Fundus photo · 50° FOV — 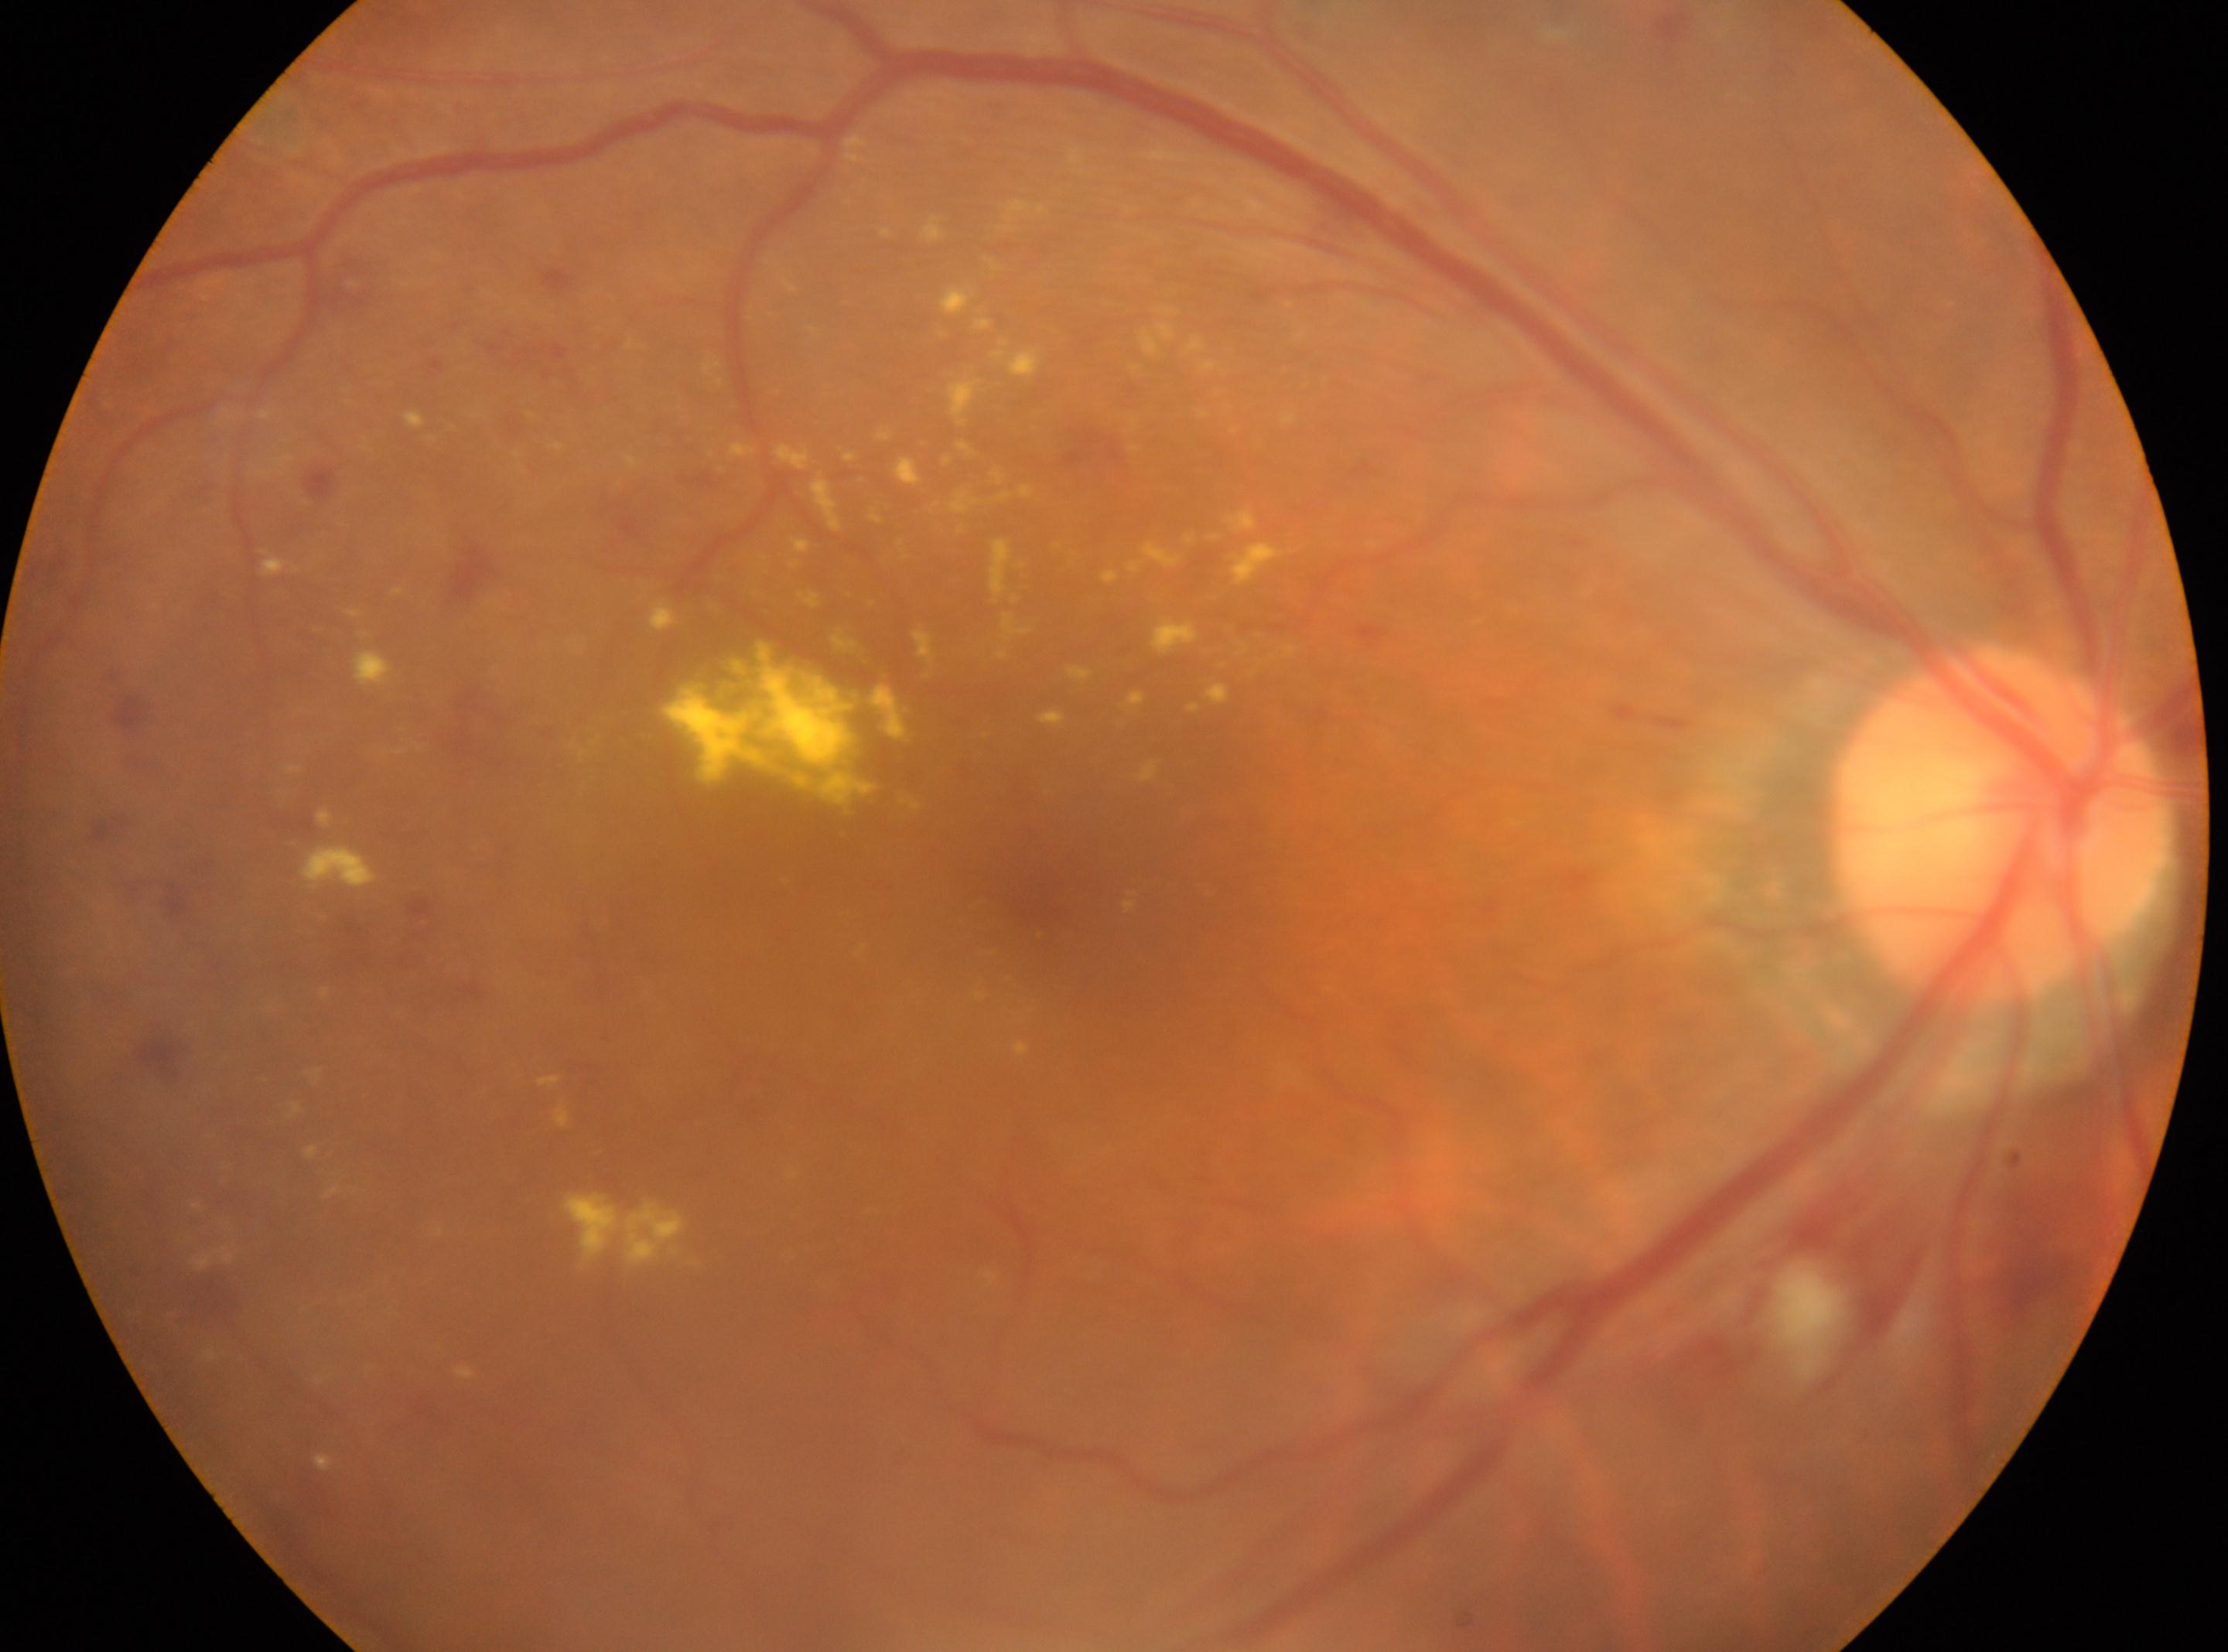 The ONH is at (1999, 826).
This is the right eye.
Macular center: (1064, 897).
DR grade: moderate NPDR (2).